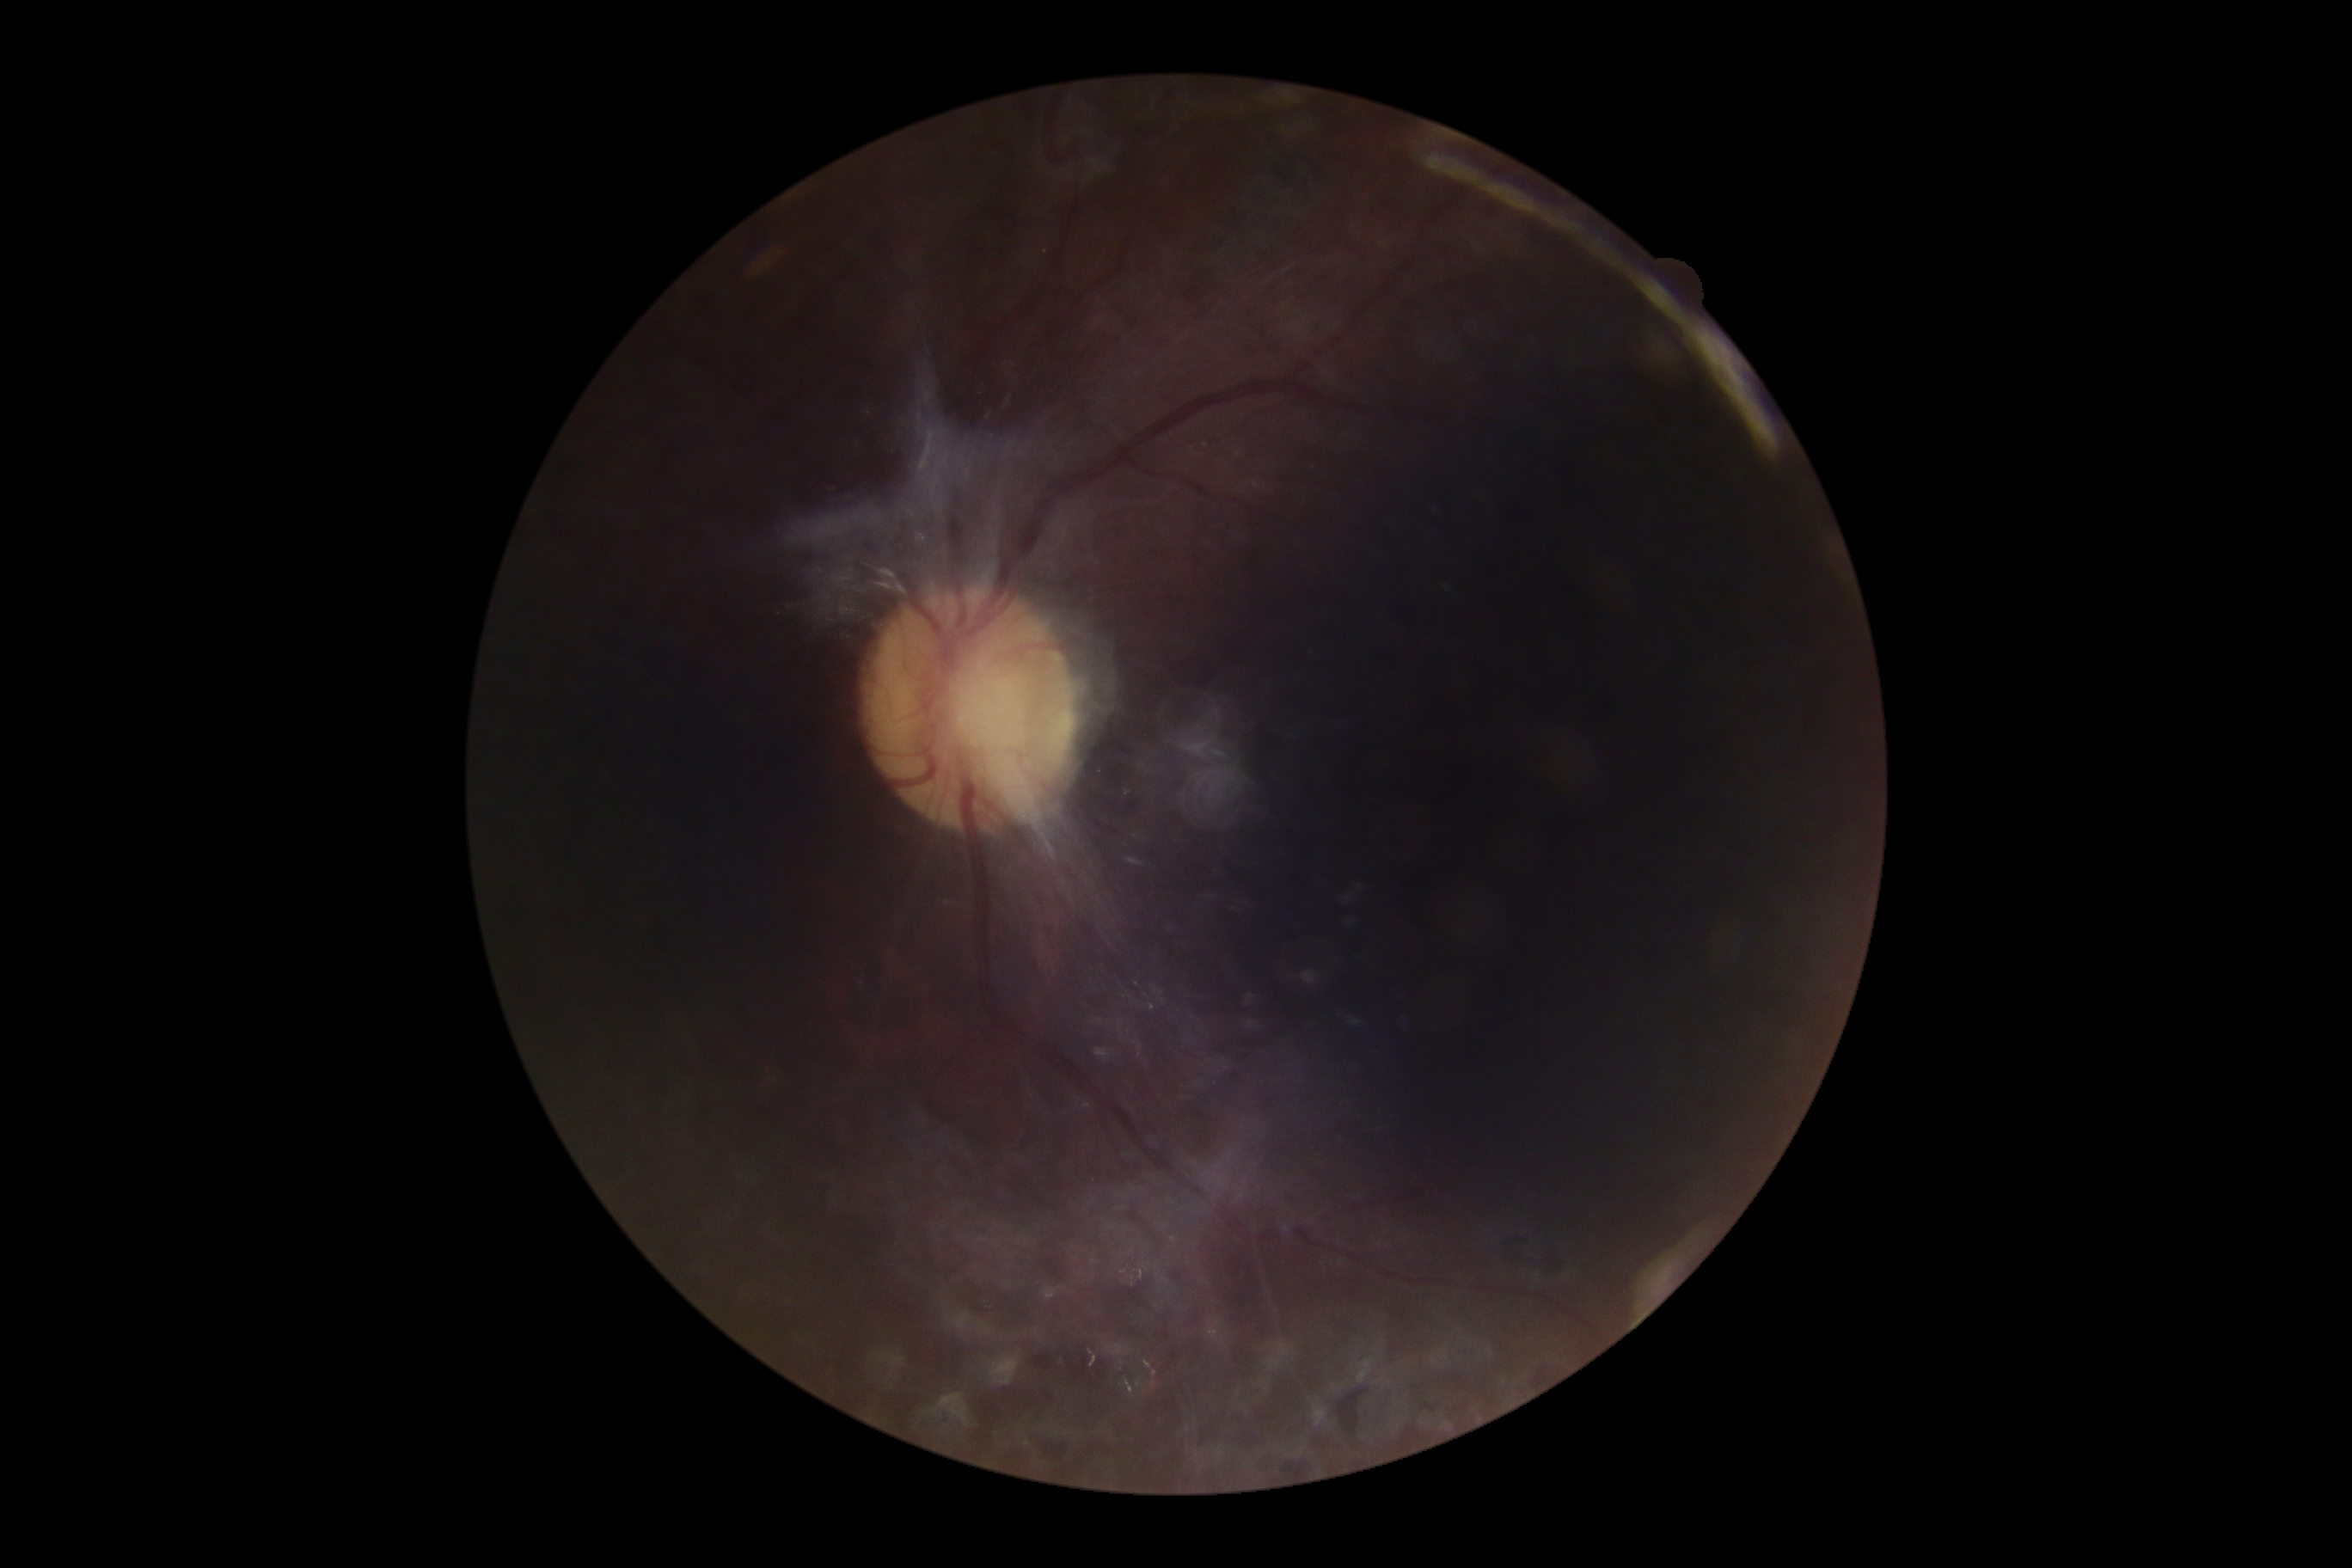

Retinopathy is grade 4 (PDR) — neovascularization and/or vitreous/pre-retinal hemorrhage.
Disease class: proliferative diabetic retinopathy.